FOV: 45 degrees
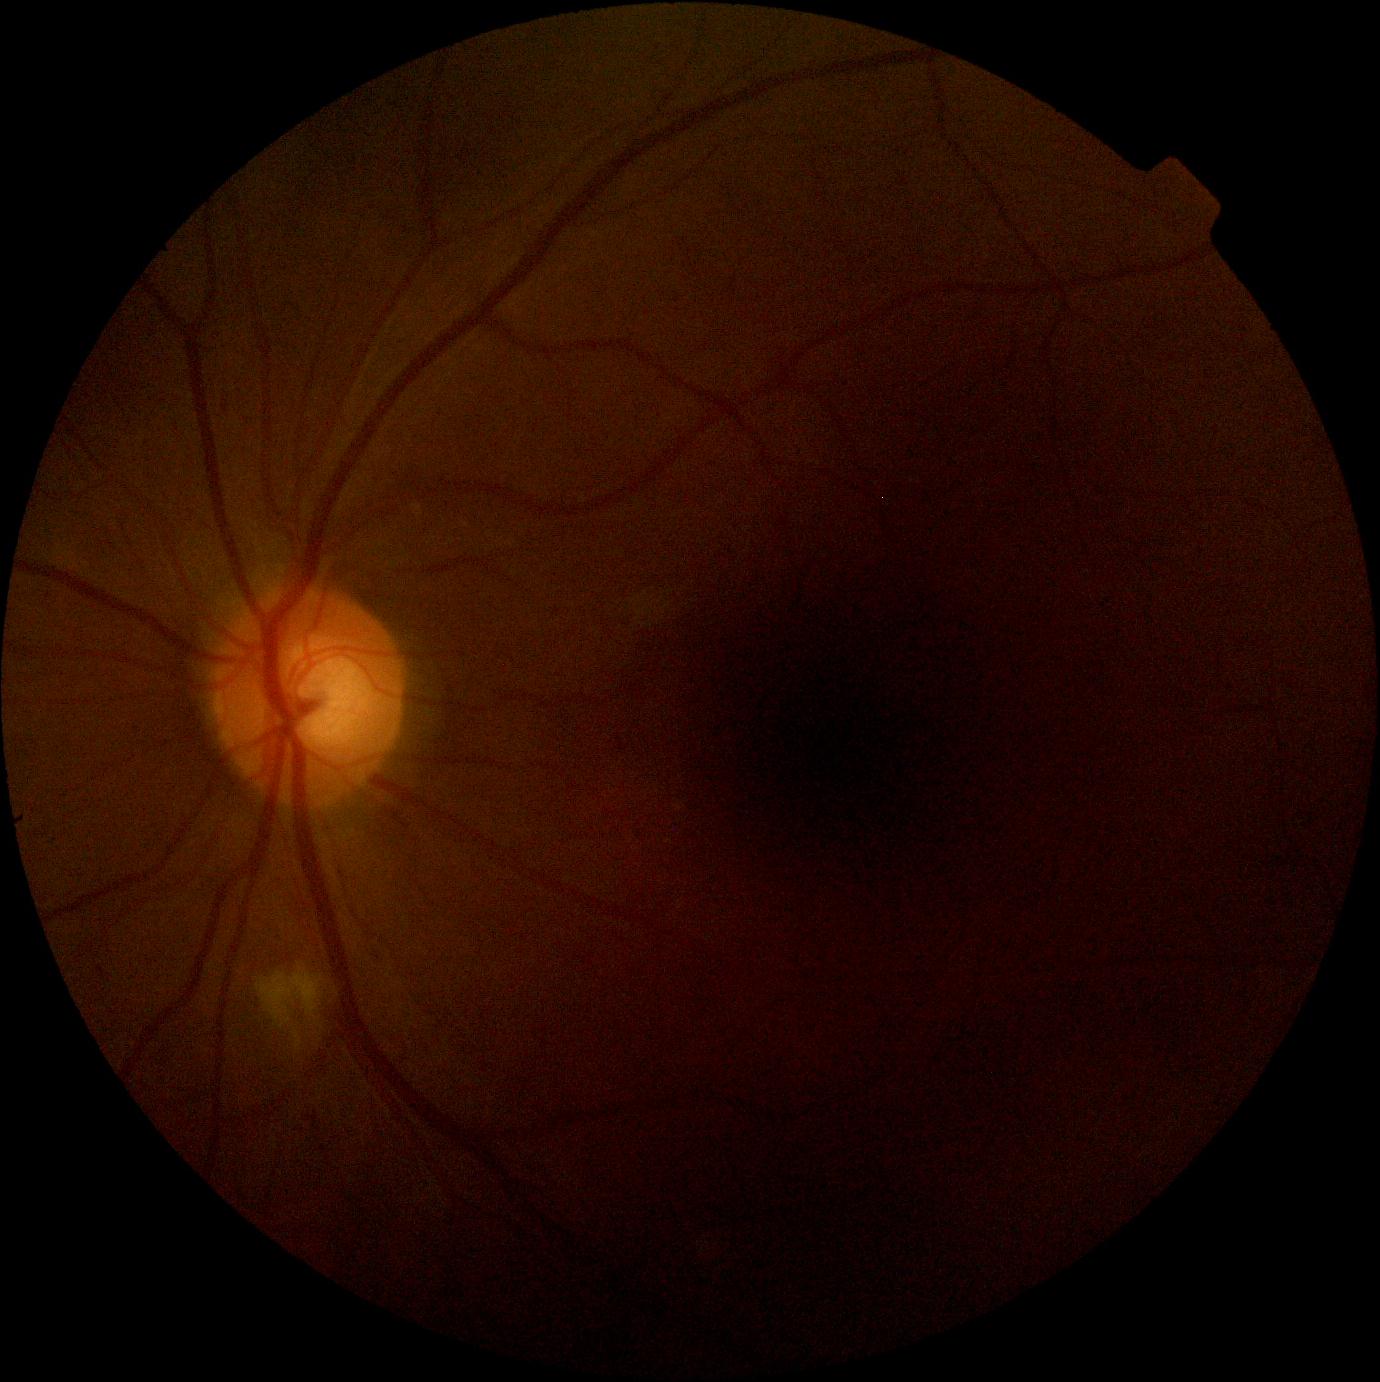
Diabetic retinopathy severity: moderate NPDR (grade 2).